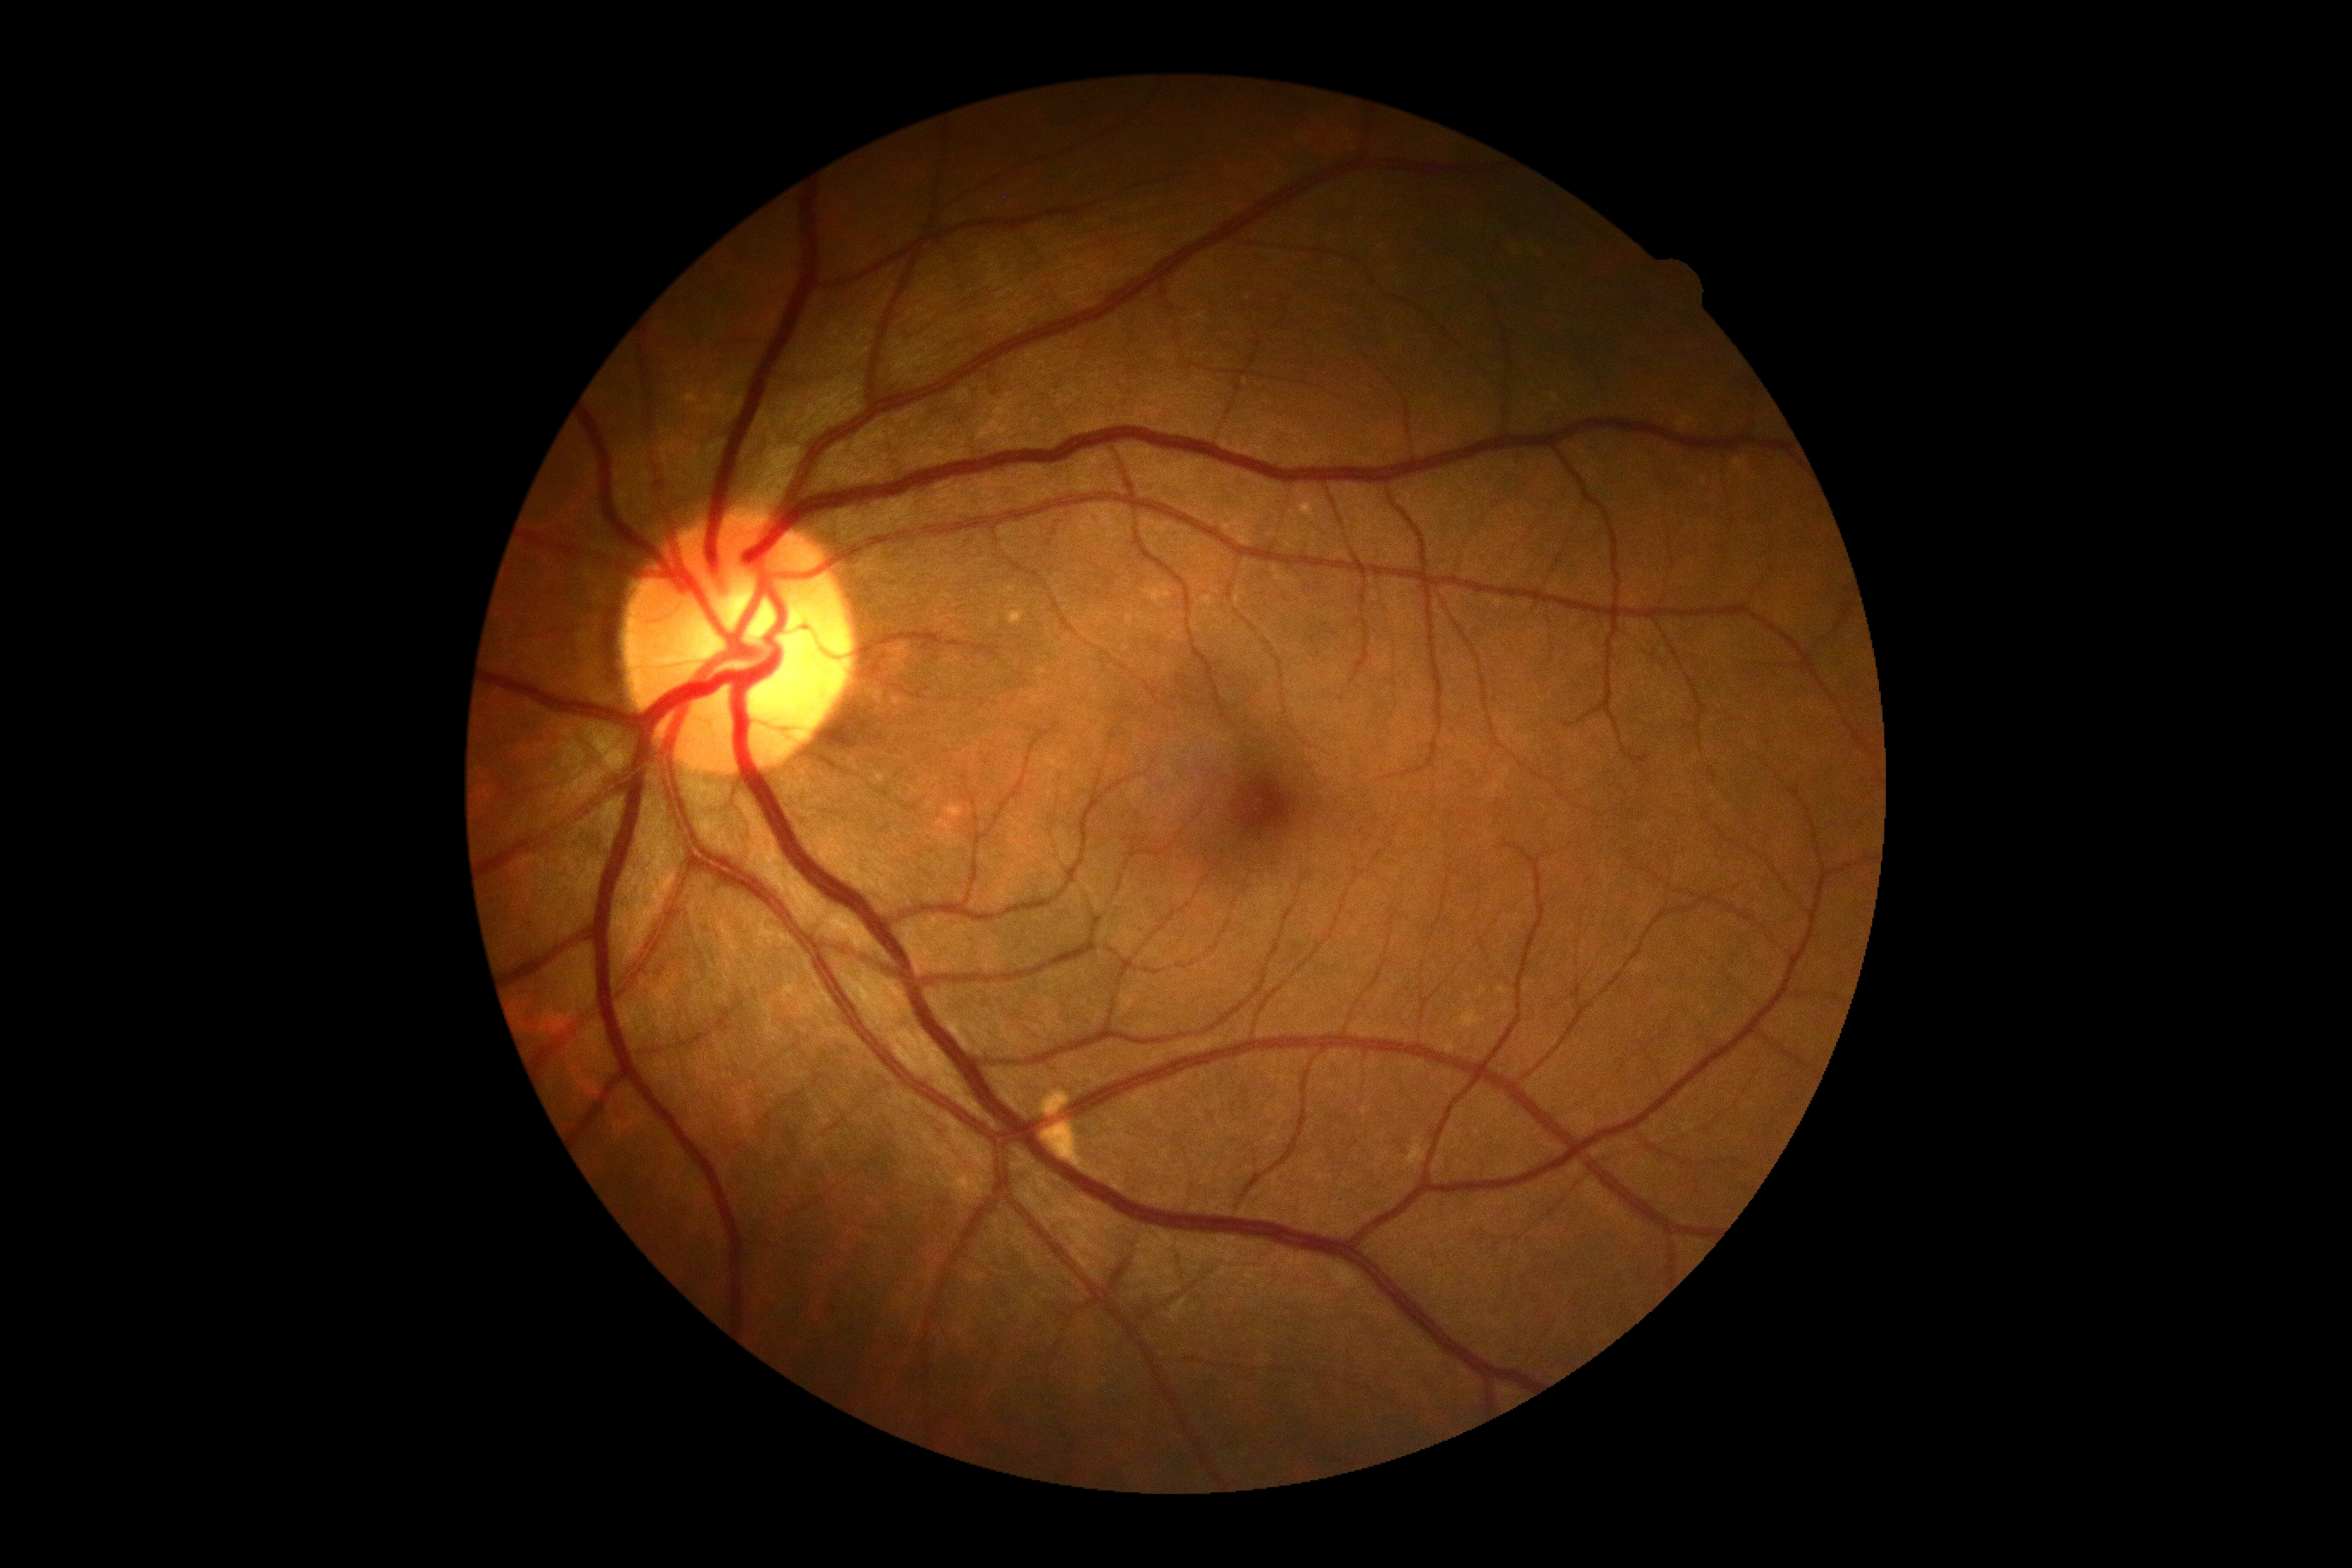
{
  "dr_grade": "no apparent retinopathy (grade 0)"
}